2212 x 1659 pixels.
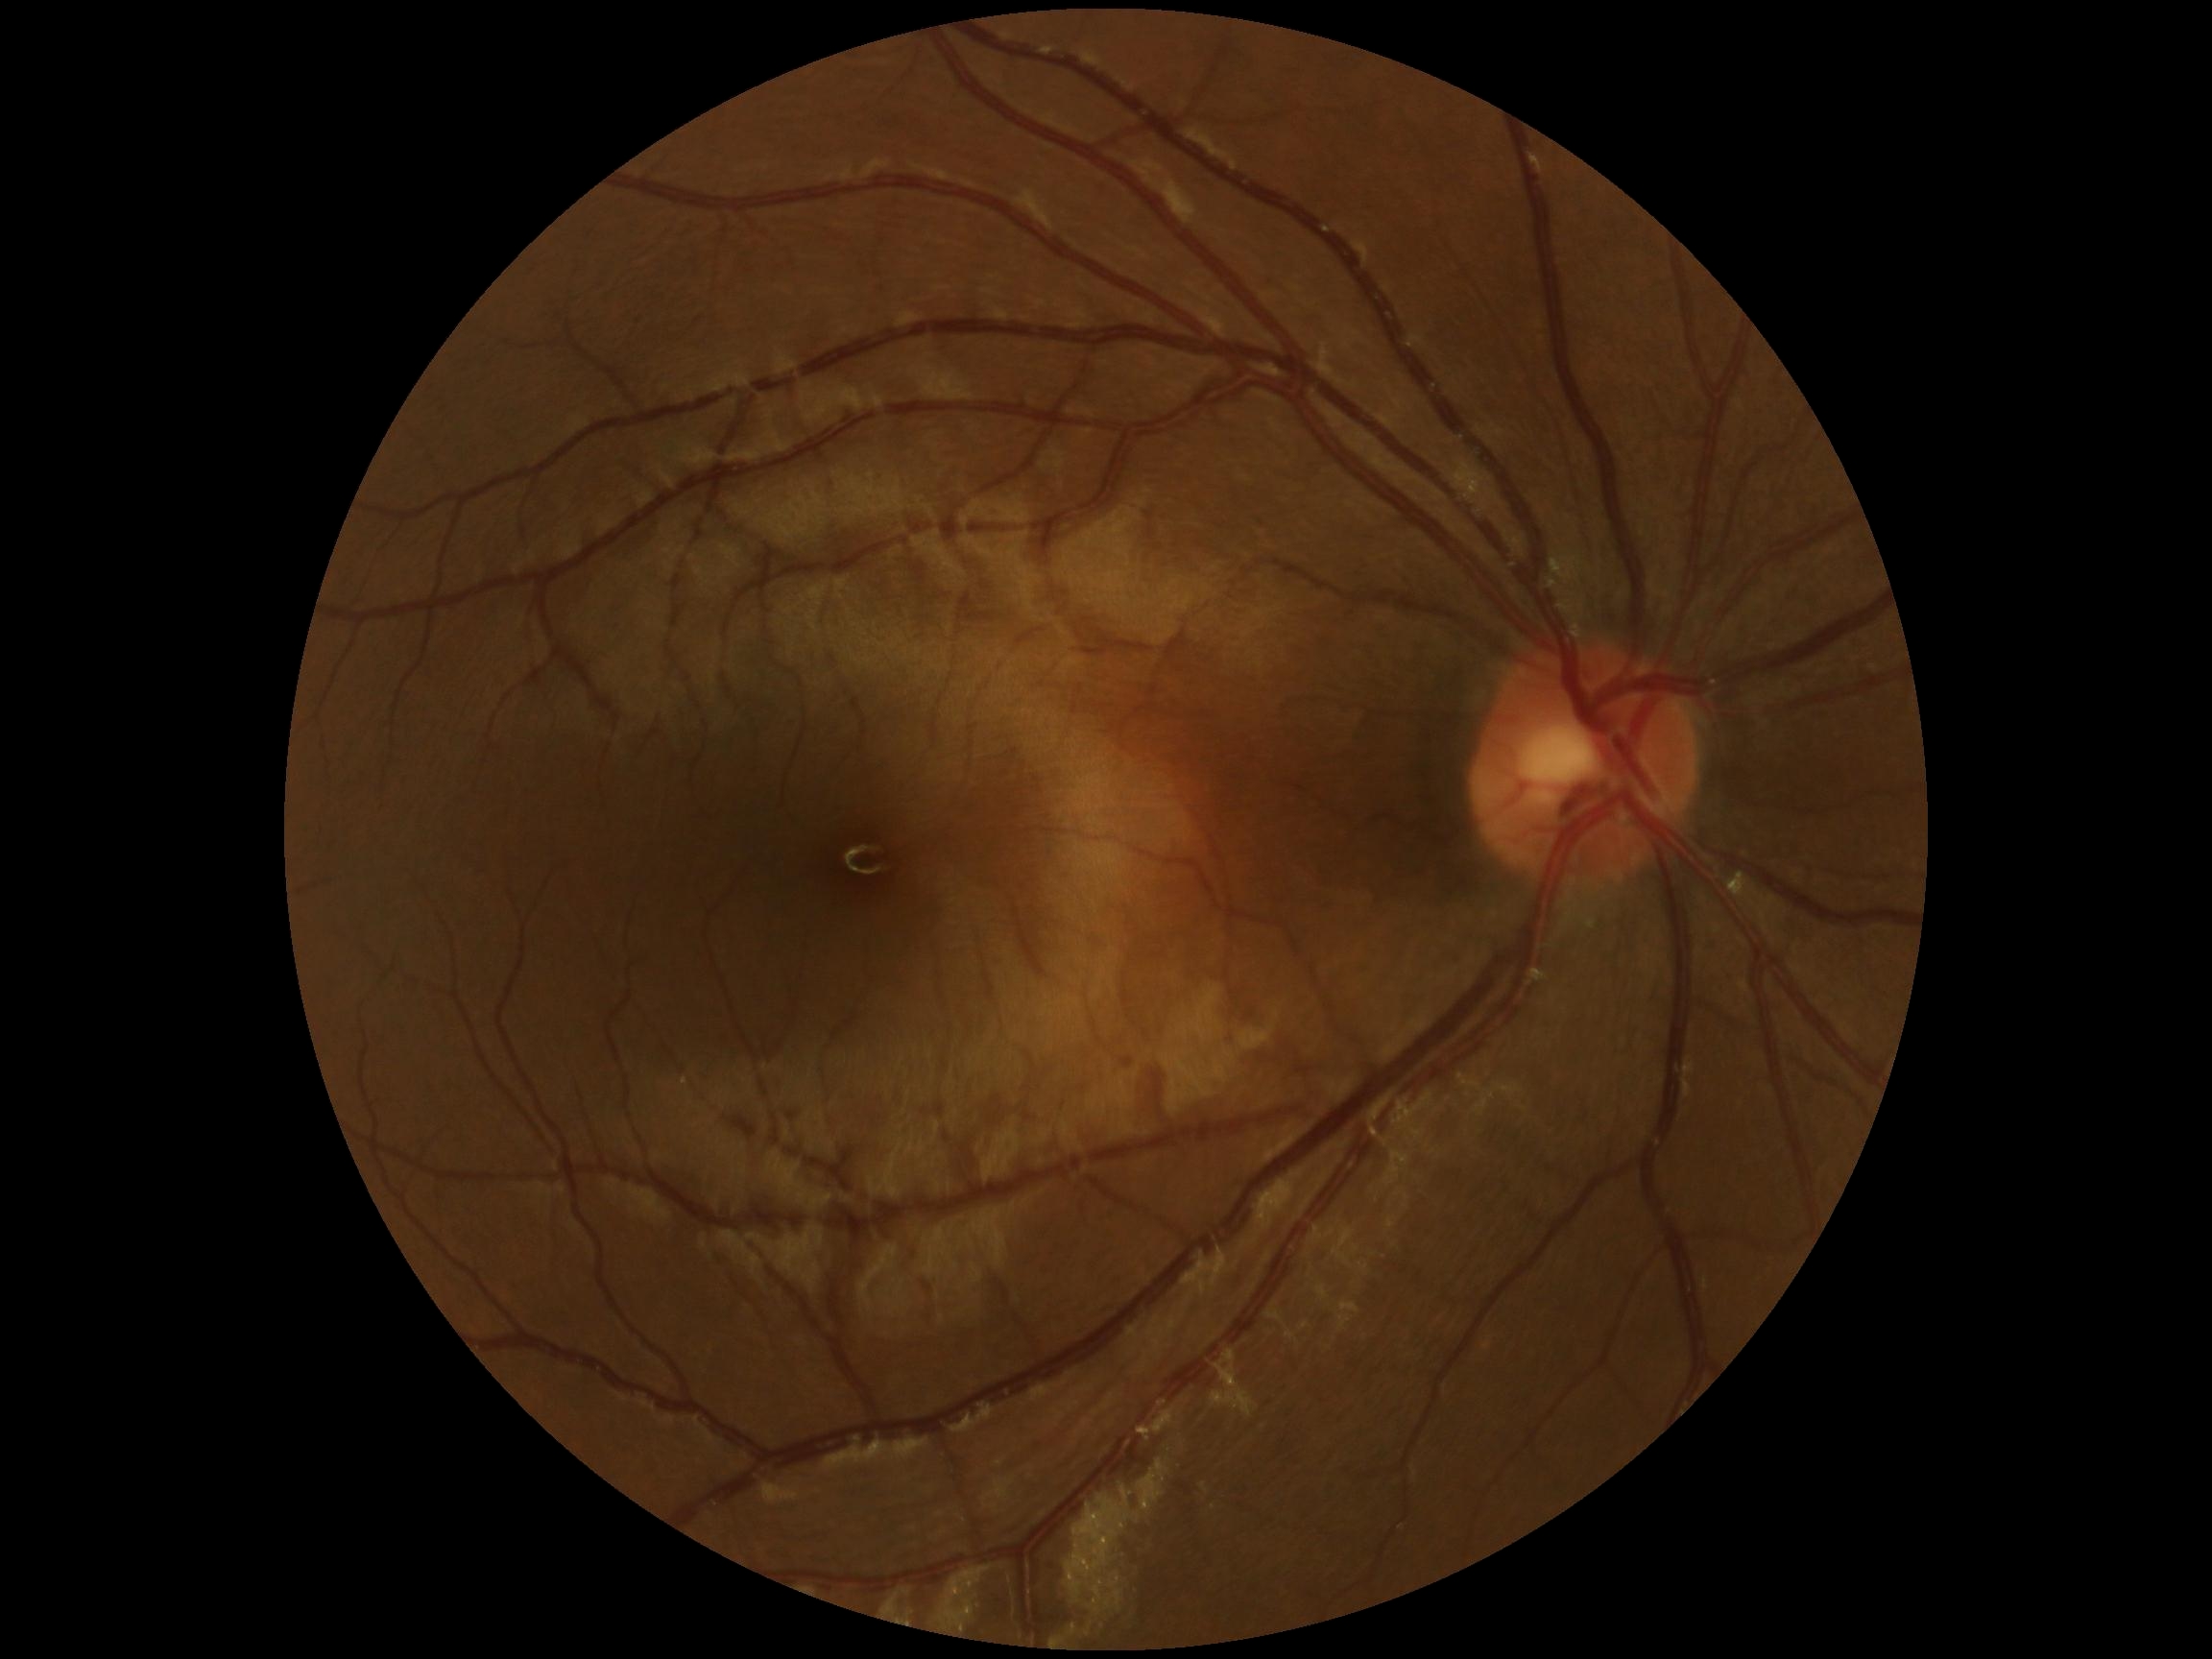 * DR impression — no DR findings
* diabetic retinopathy (DR) — 0/4